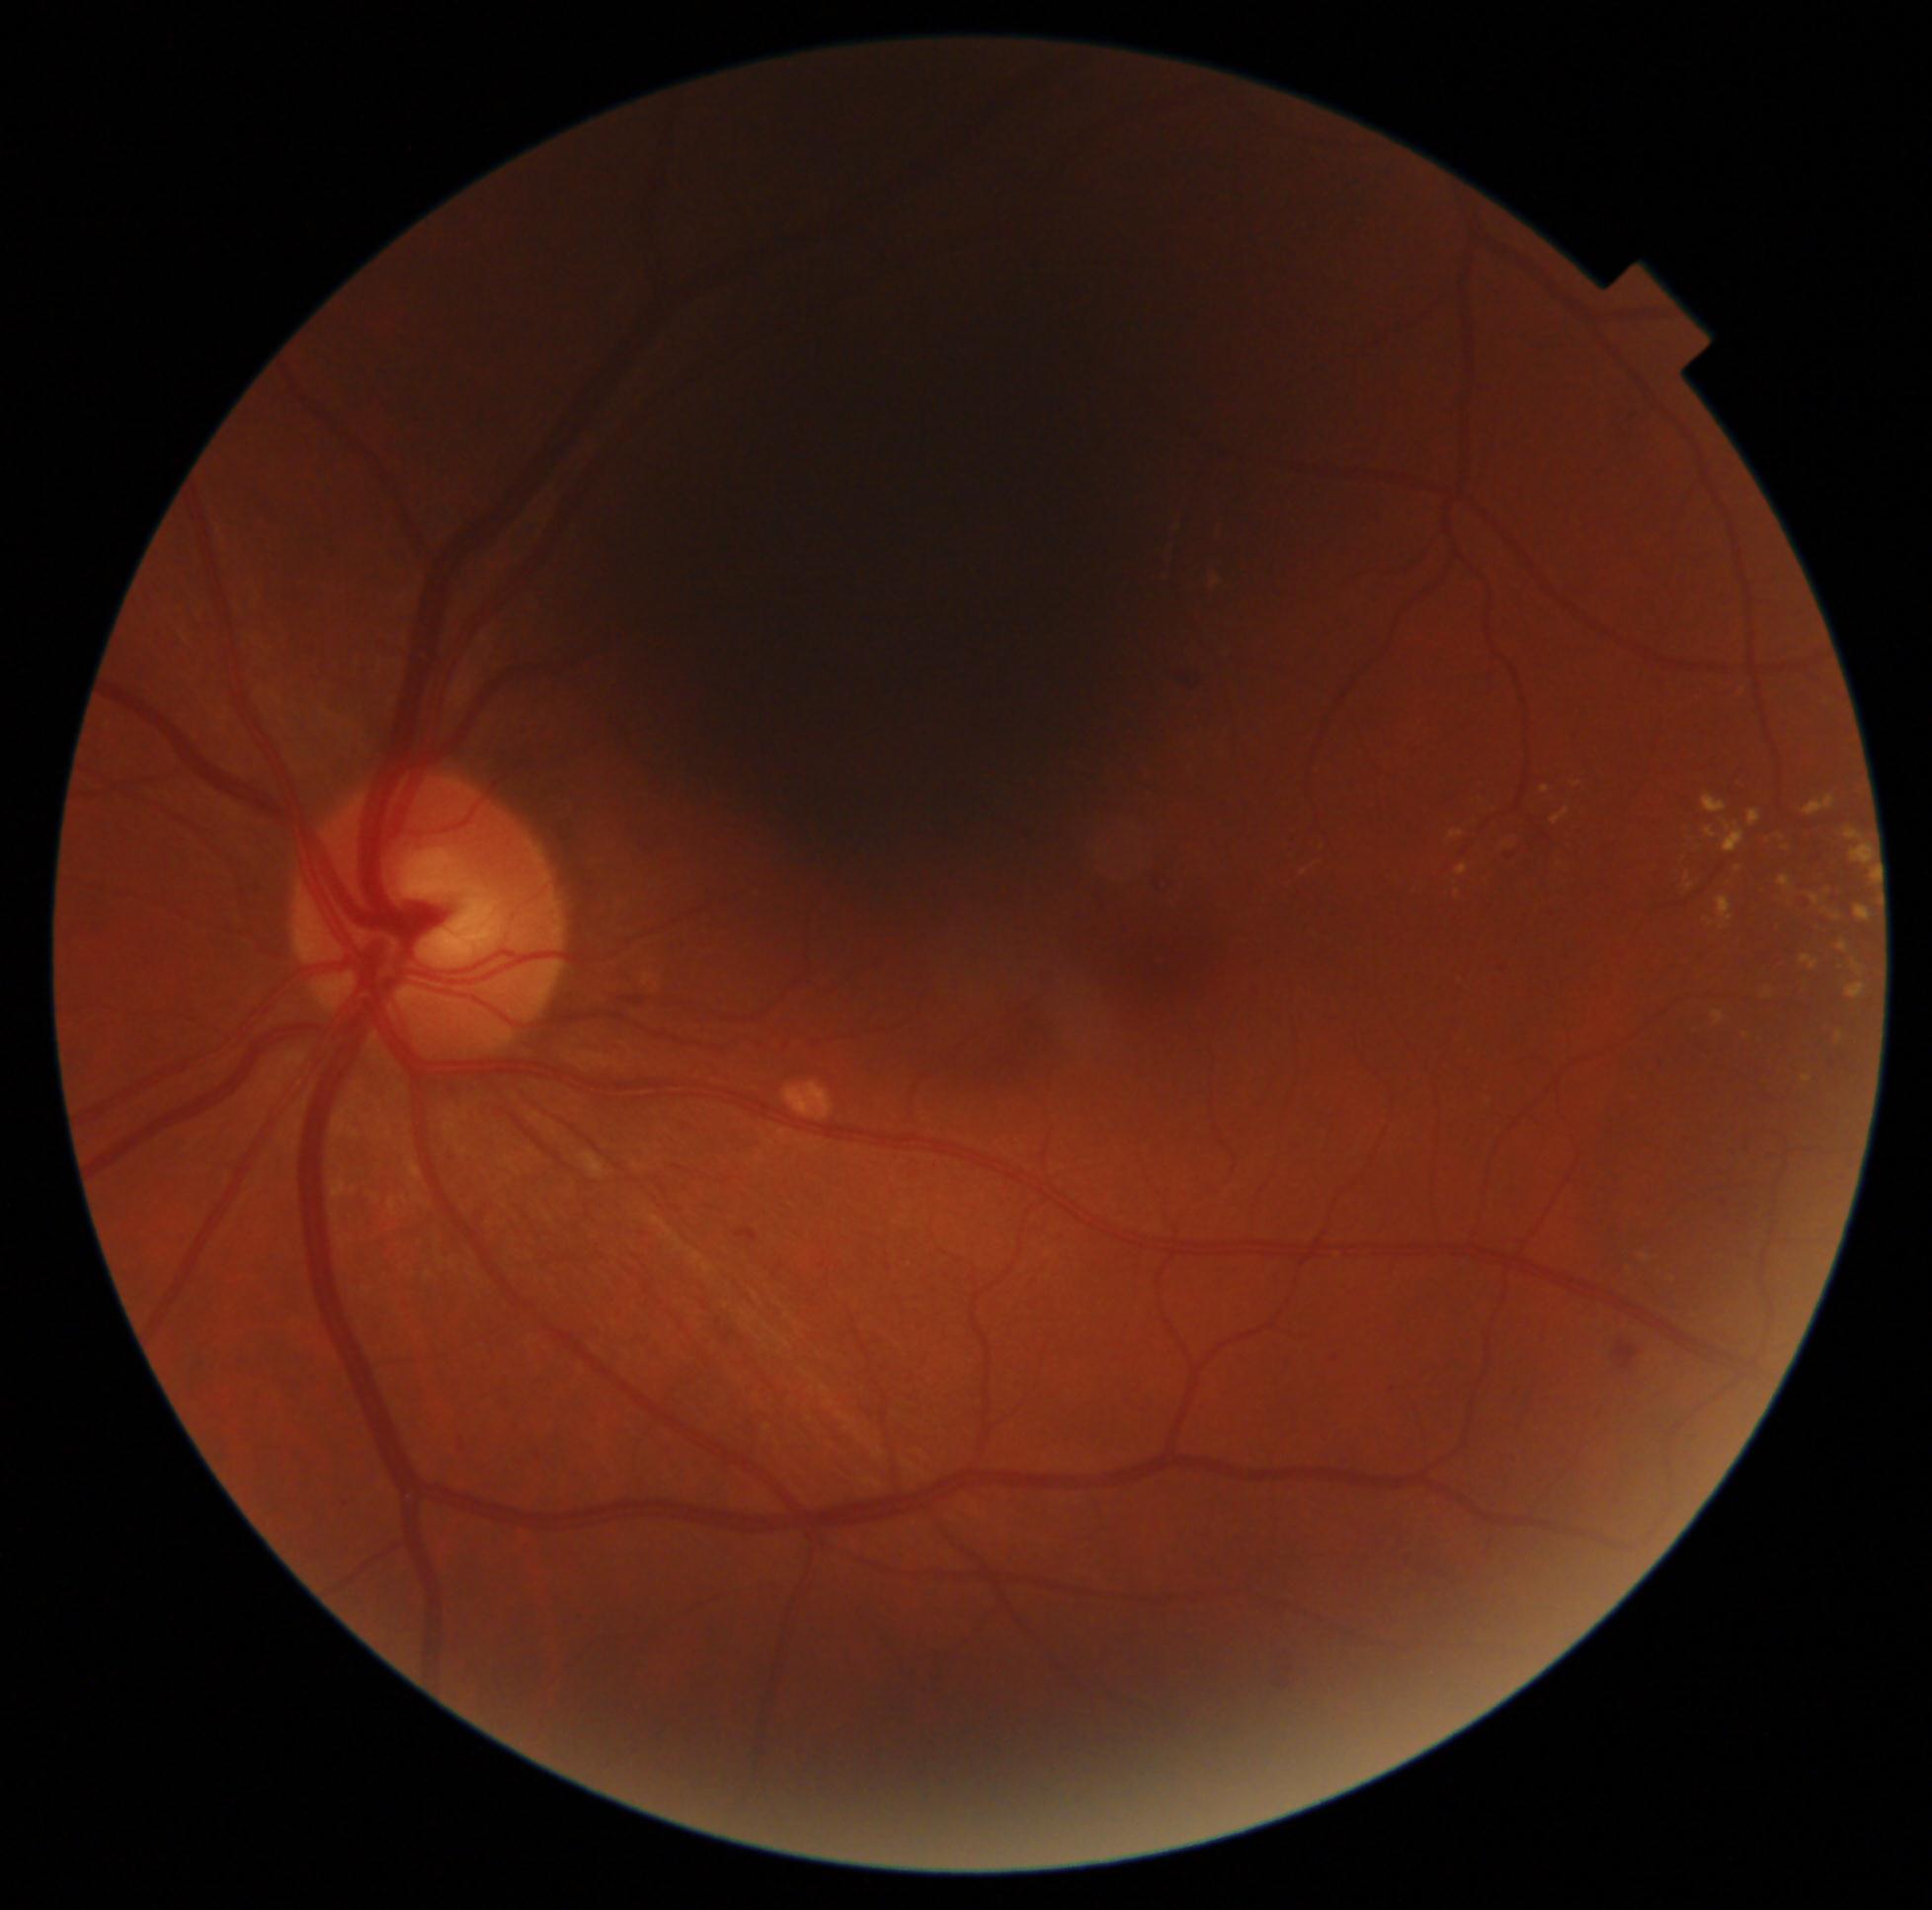
Retinopathy grade is 2.